2352 x 1568 pixels · color fundus image
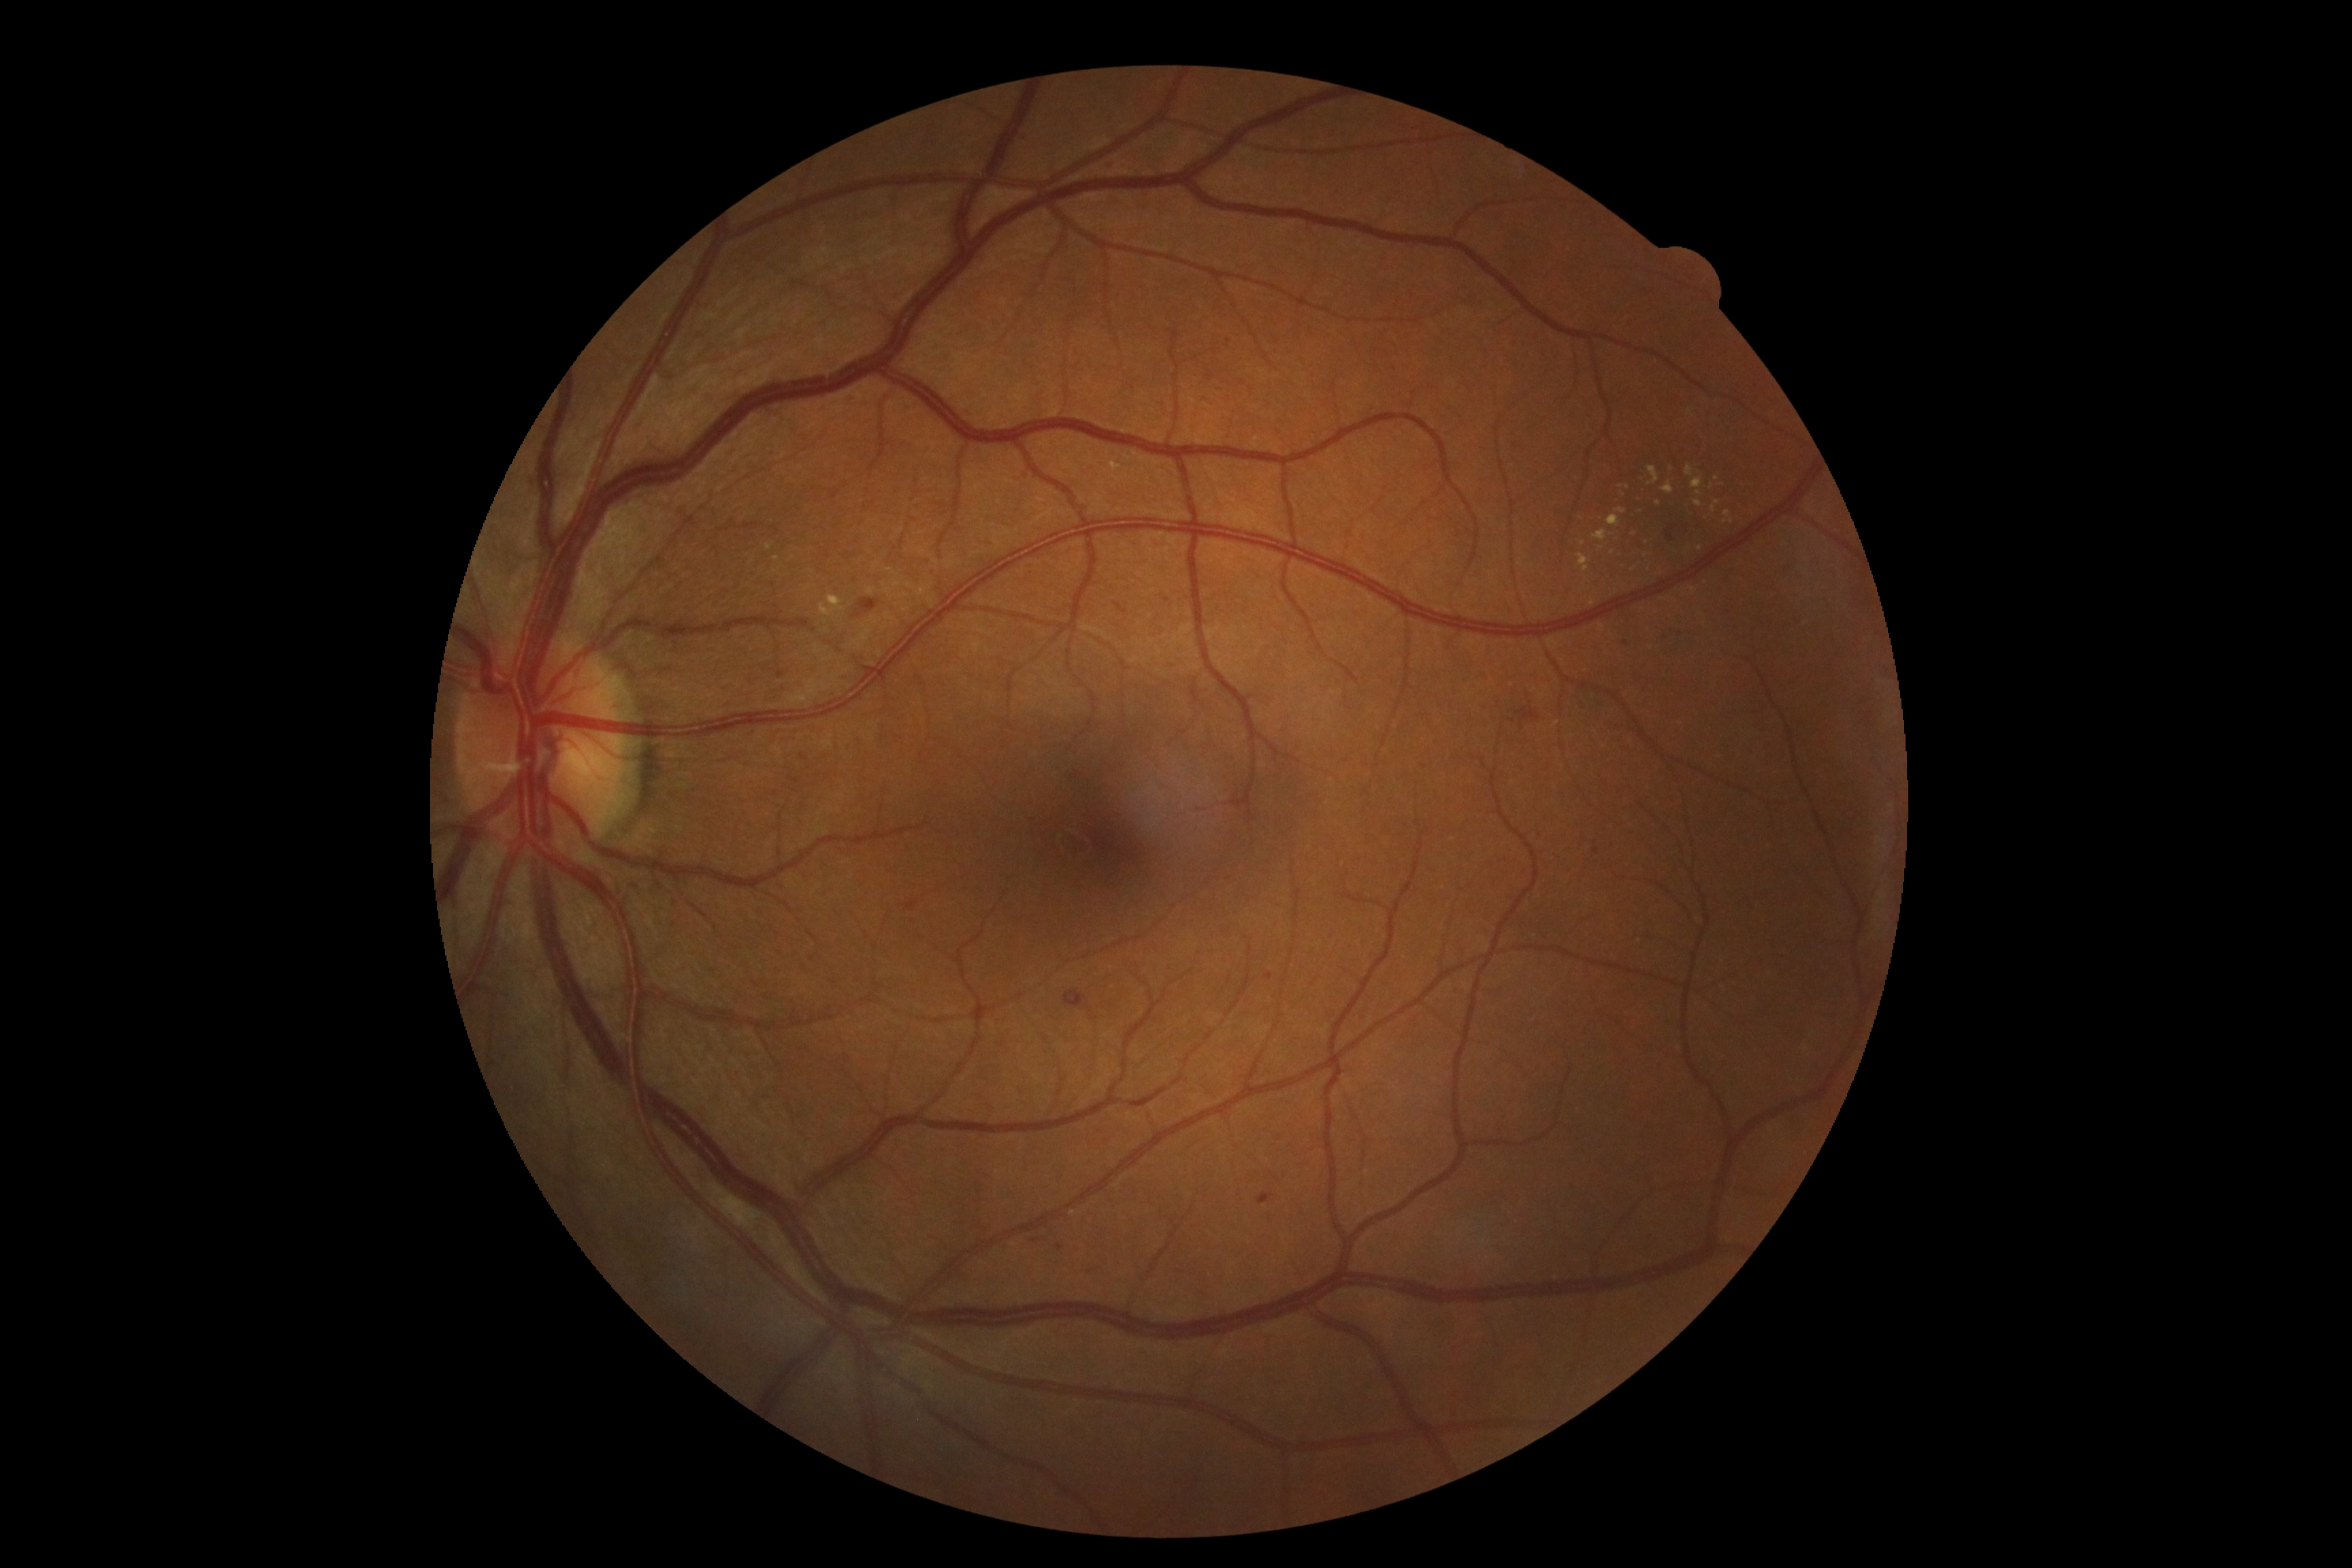 dr_category: non-proliferative diabetic retinopathy
dr_grade: grade 2 (moderate NPDR) — more than just microaneurysms but less than severe NPDR